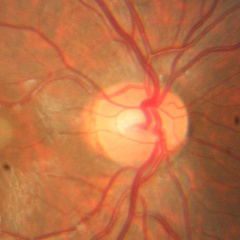

Glaucoma assessment = no glaucomatous changes.